1932x1910px; retinal fundus photograph; FOV: 45 degrees: 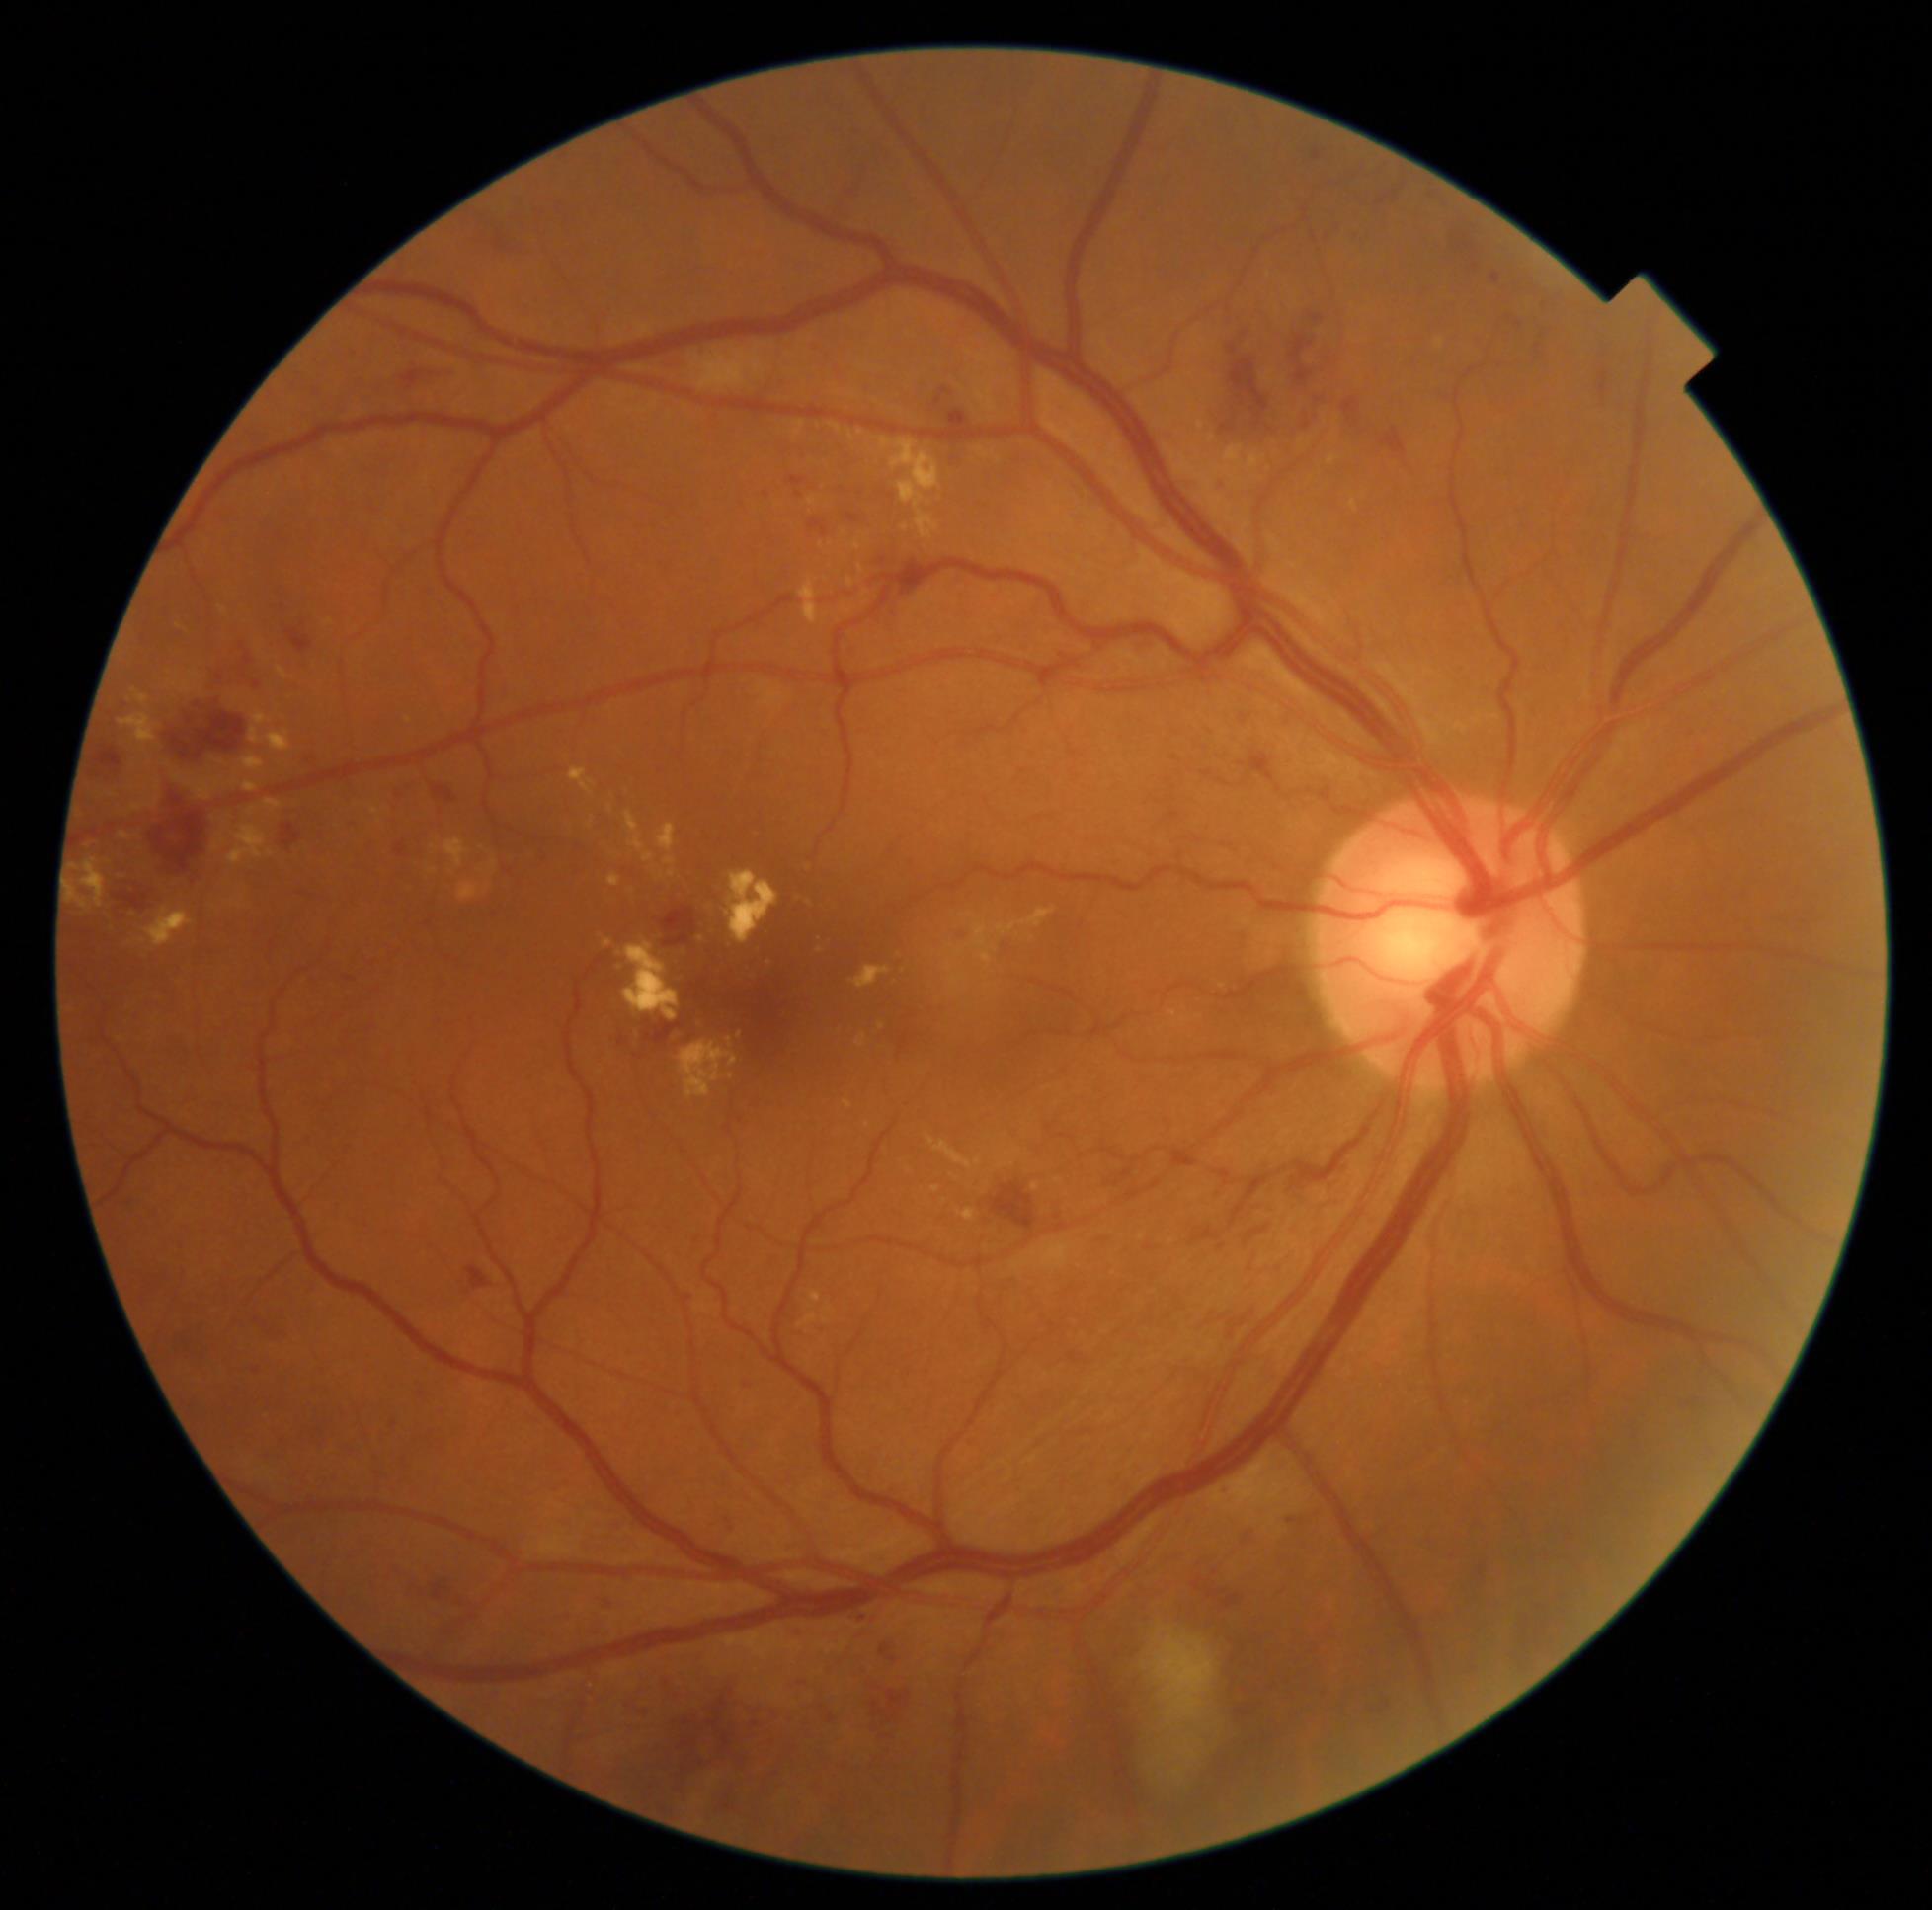
Retinopathy: 2/4.